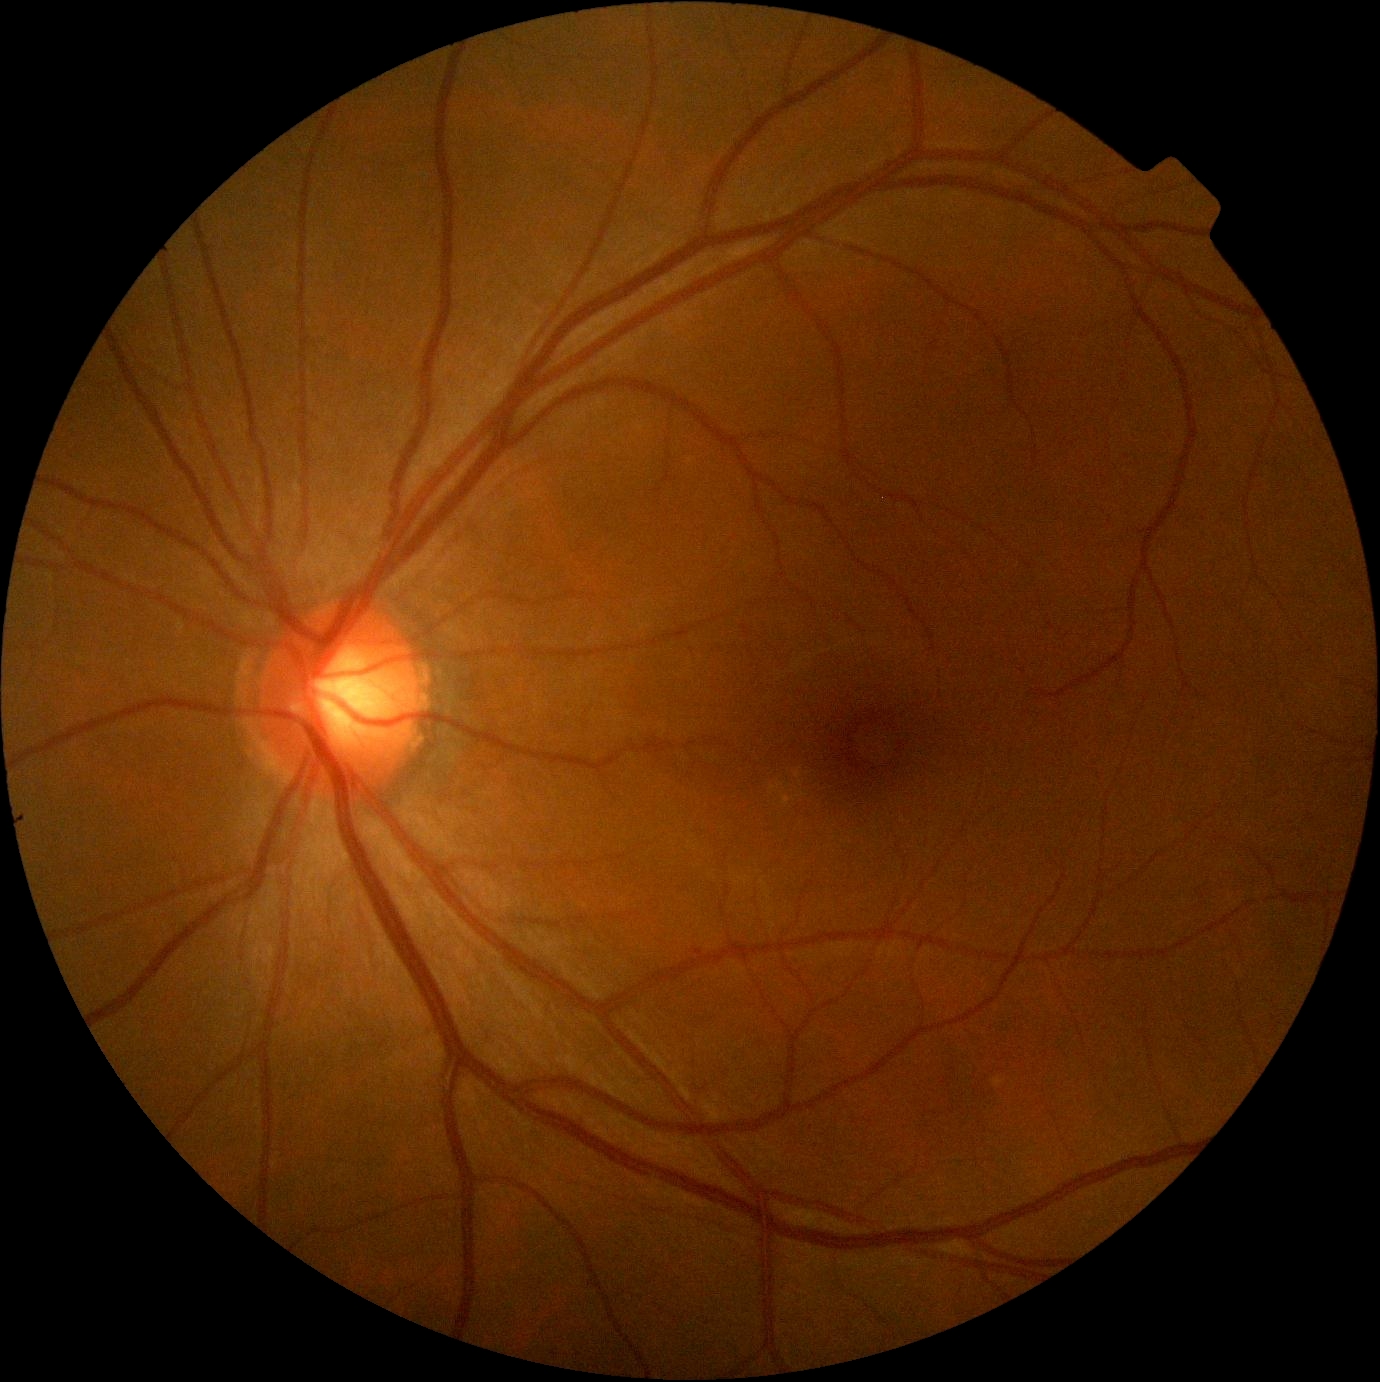 No DR findings.
DR stage is grade 0 (no apparent retinopathy).